Color fundus photograph:
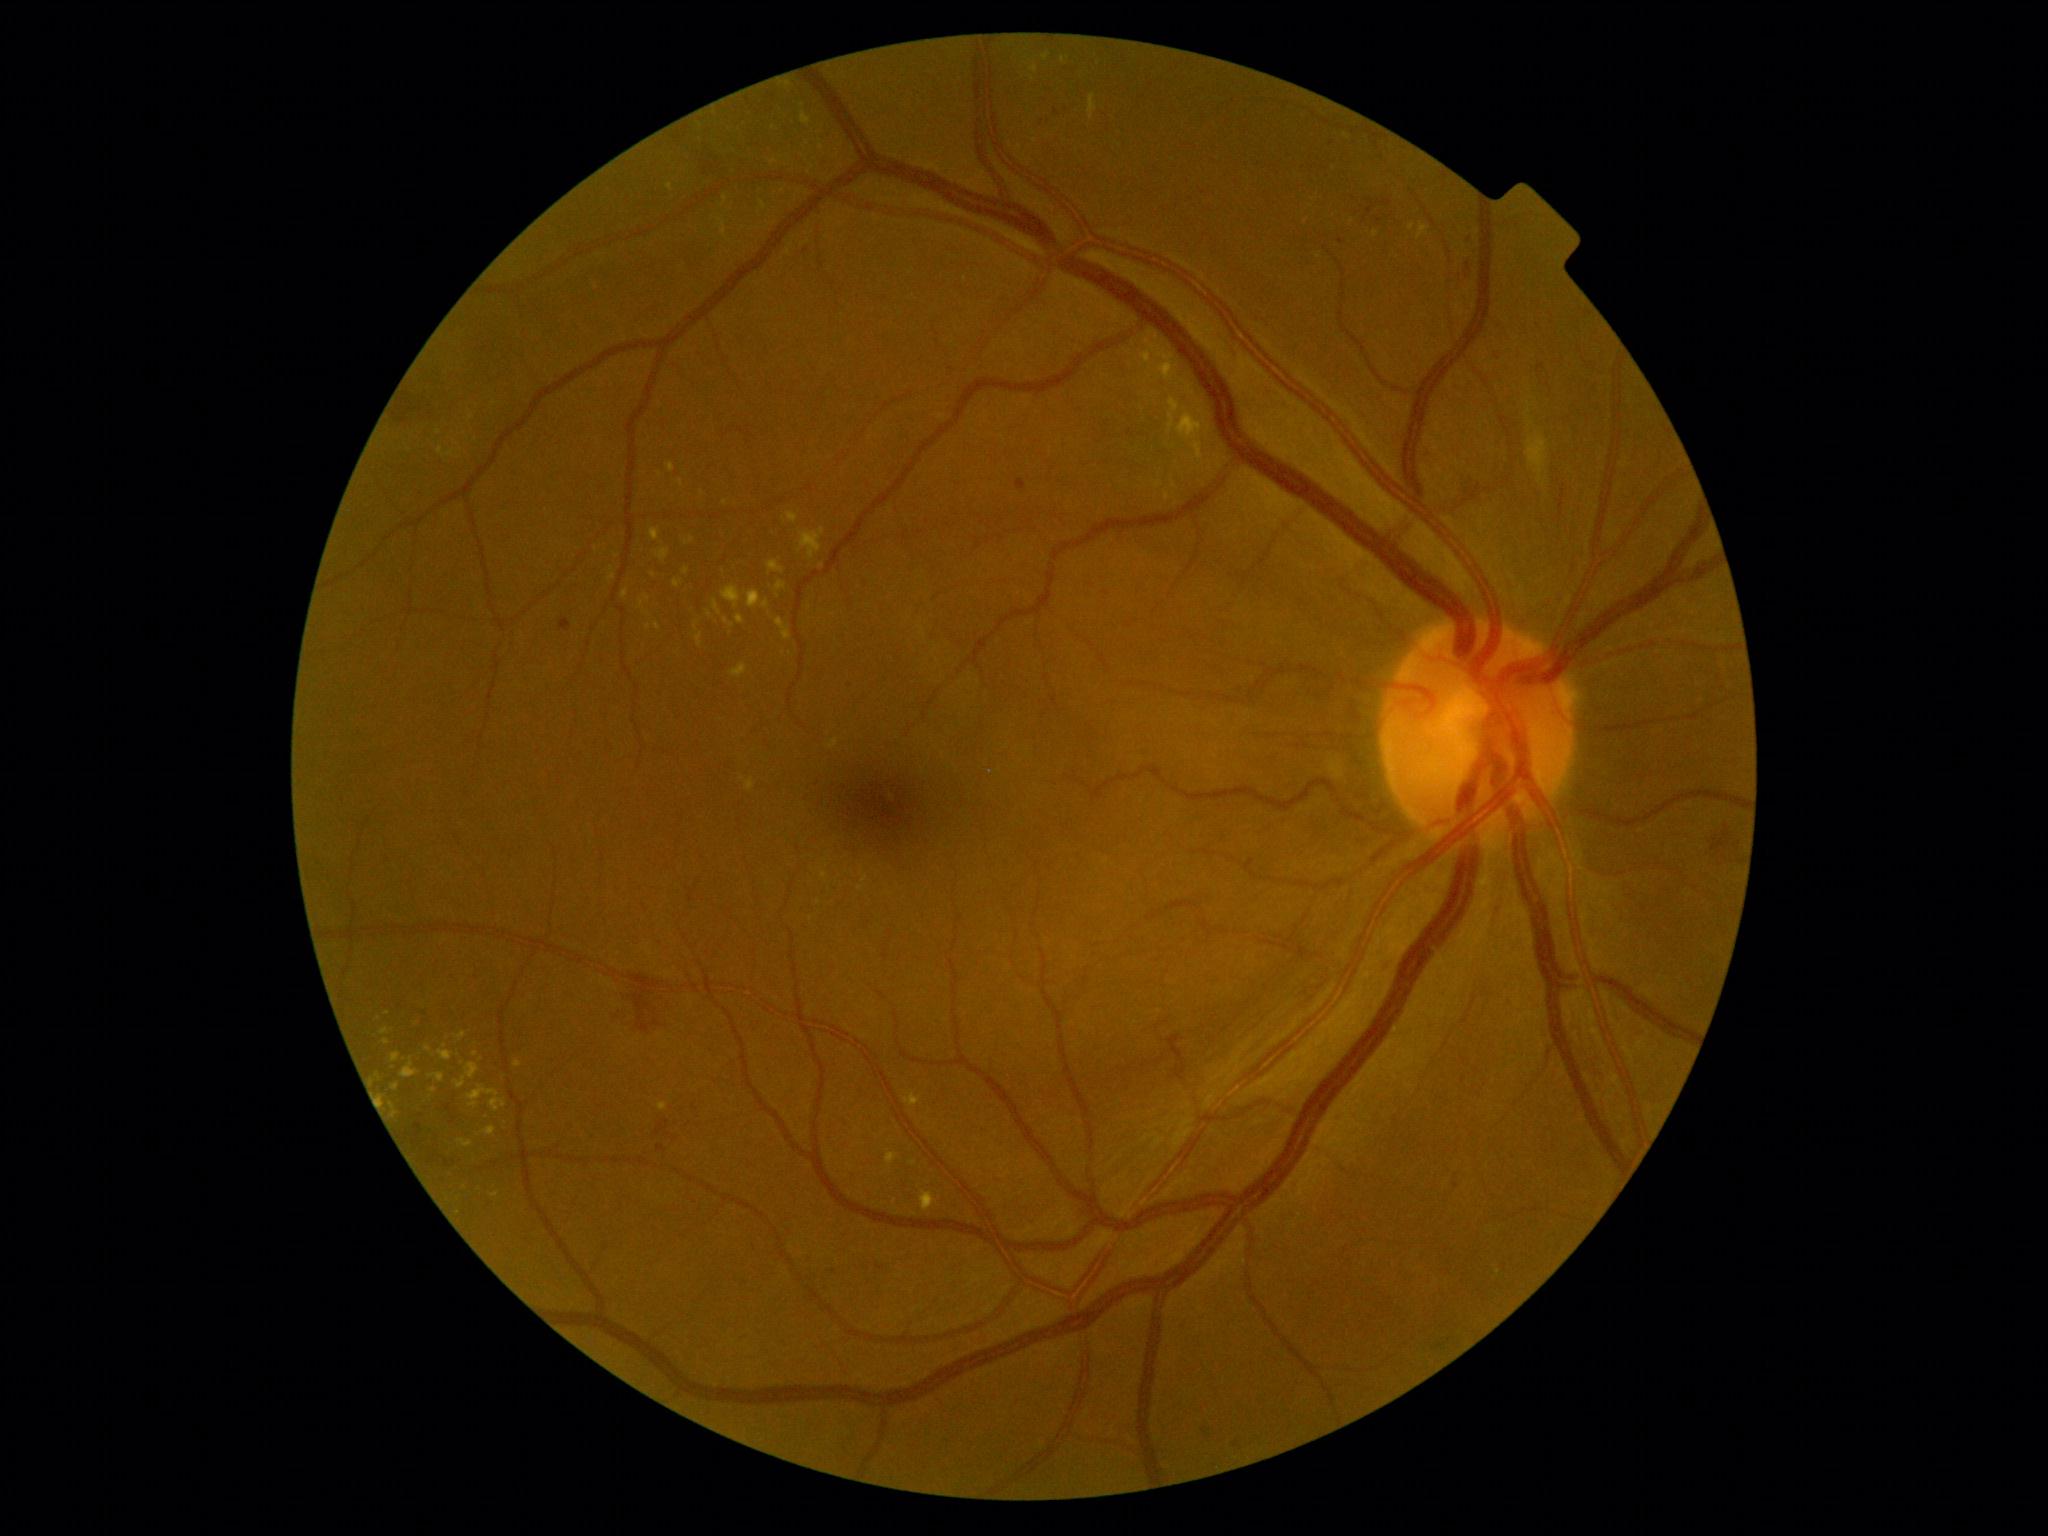

Diabetic retinopathy (DR): grade 2 — more than just microaneurysms but less than severe NPDR
A subset of detected lesions:
hard exudates (EXs) (continued): x1=439, y1=1051, x2=453, y2=1061; x1=379, y1=1095, x2=384, y2=1106; x1=686, y1=536, x2=694, y2=546; x1=776, y1=582, x2=786, y2=598; x1=482, y1=1127, x2=496, y2=1136; x1=391, y1=1052, x2=401, y2=1062; x1=747, y1=591, x2=762, y2=609; x1=1417, y1=224, x2=1429, y2=240; x1=455, y1=1062, x2=480, y2=1090; x1=737, y1=615, x2=746, y2=625; x1=667, y1=183, x2=674, y2=192
Additional small EXs near [372,1082]; [1034,69]; [480,1189]; [1347,136]; [1411,228]; [649,628]; [378,1076]; [476,1054]